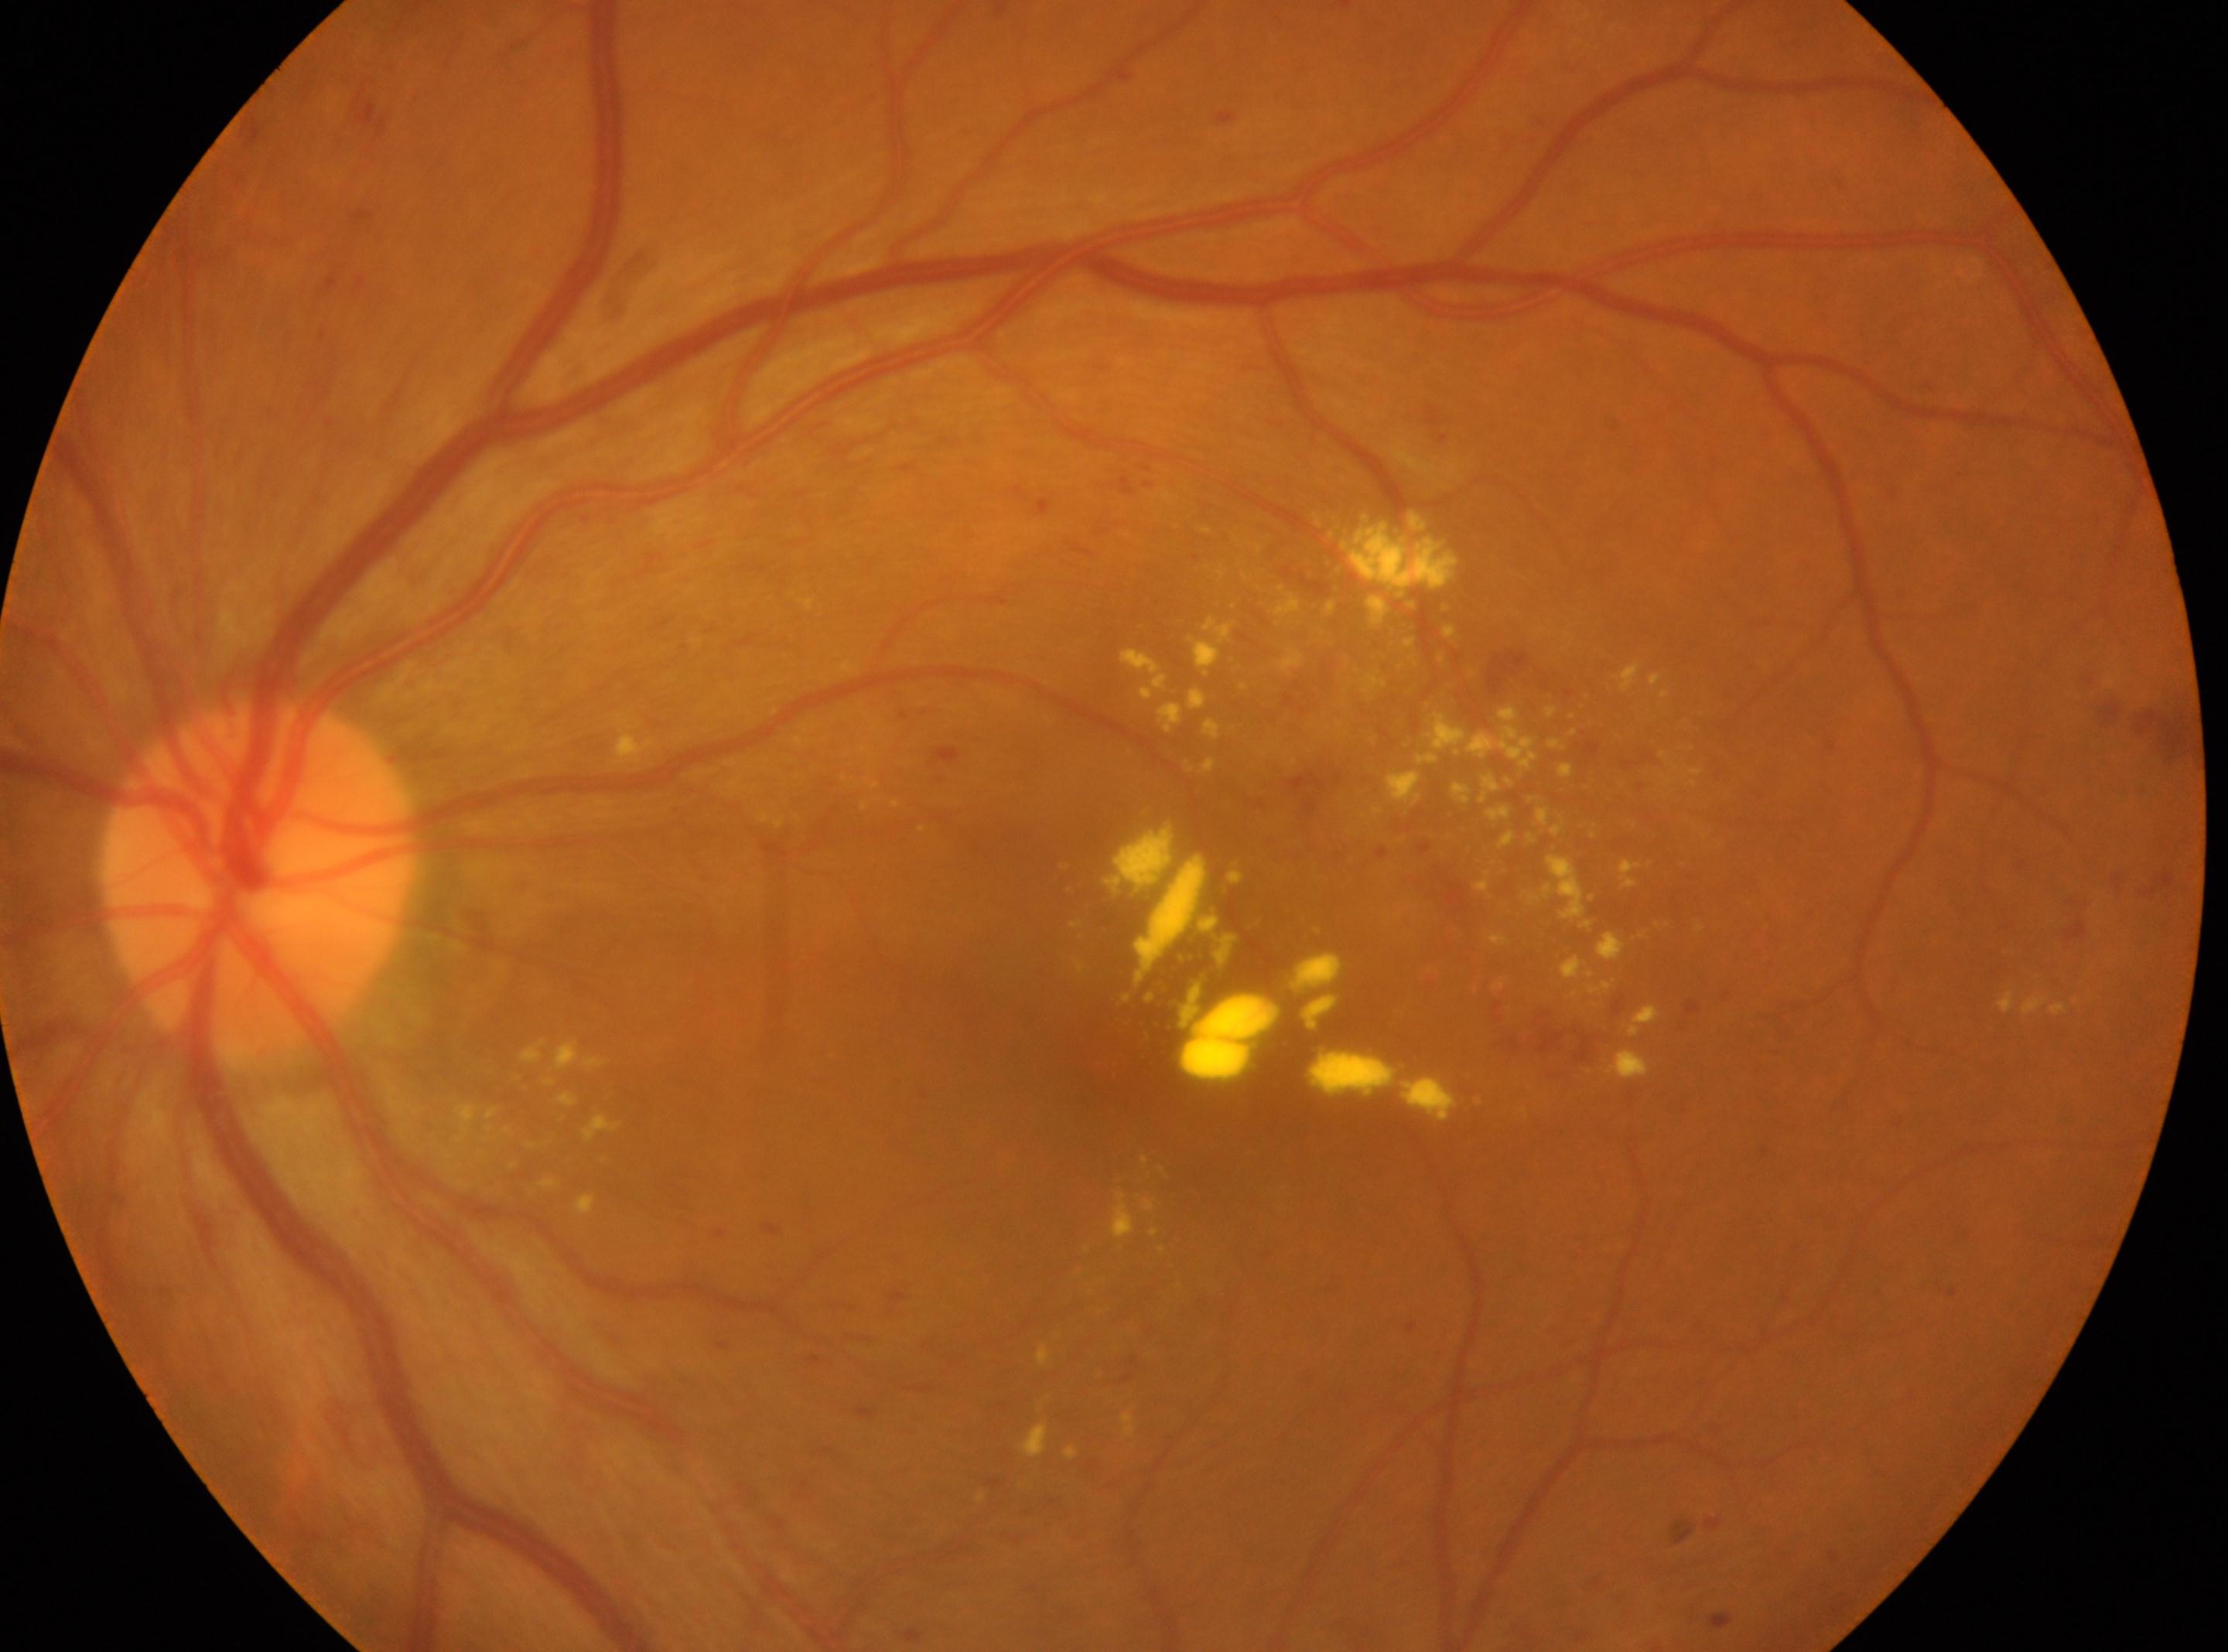
DR grade: 2 (moderate NPDR).
The image shows the left eye.
The fovea is at 1116px, 1061px.
Optic disc located at 257px, 881px.